Image size 1240x1240 · acquired on the Phoenix ICON · Phoenix ICON wide-field infant fundus image.
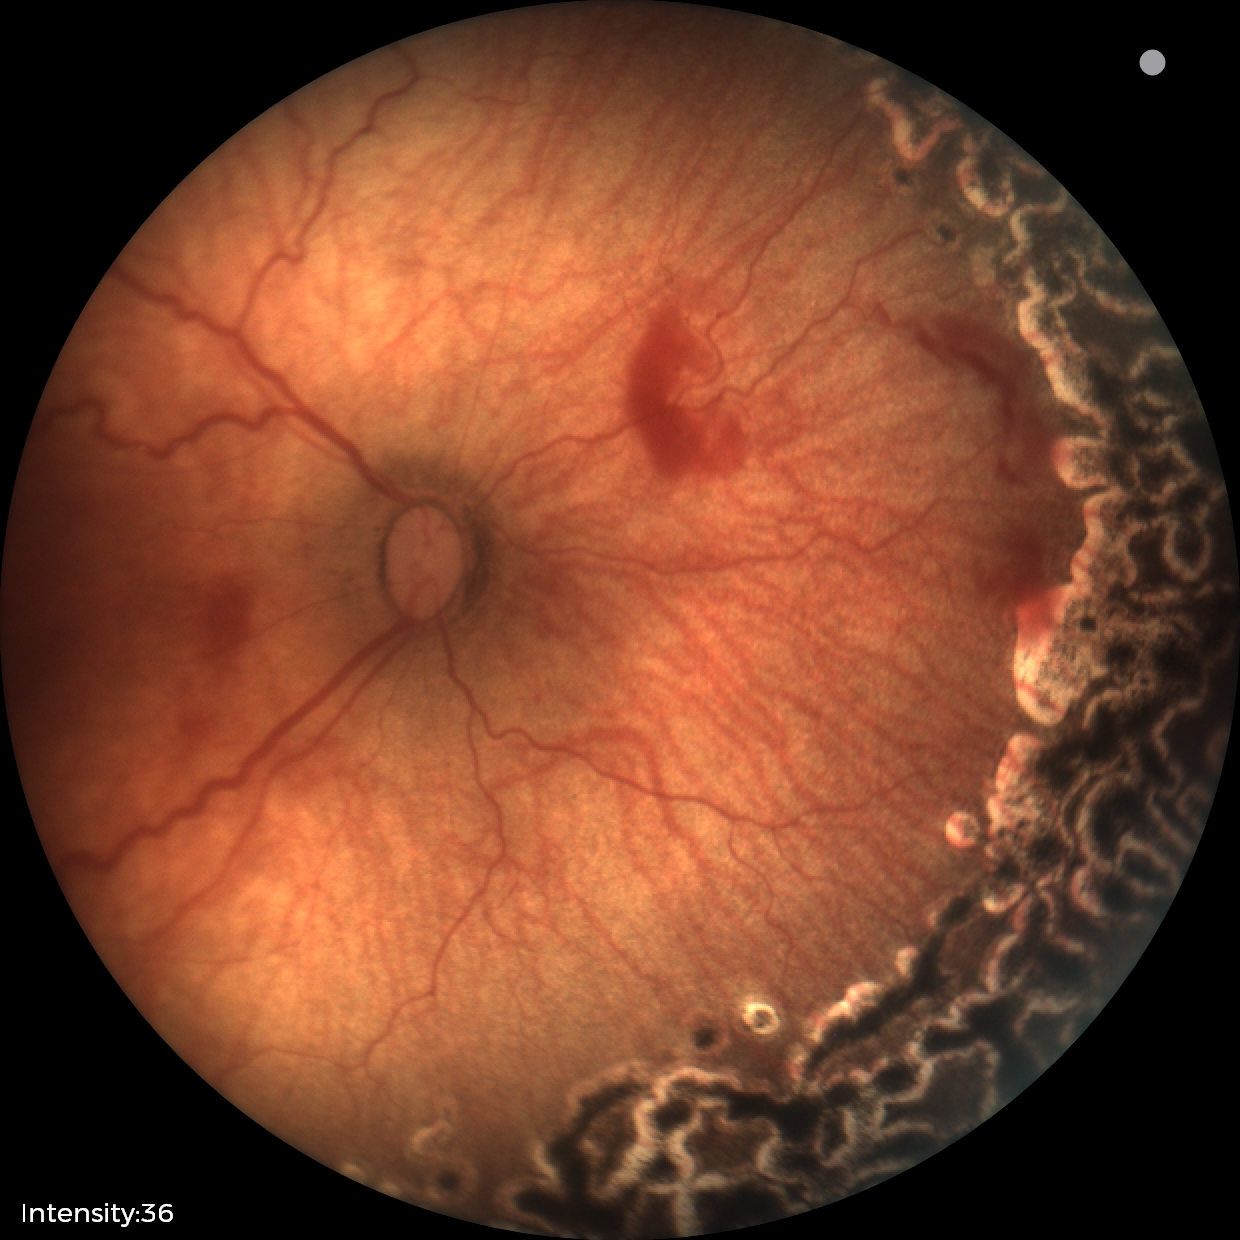
Q: What is the diagnosis from this examination?
A: status post retinopathy of prematurity — retinal appearance after treated retinopathy of prematurity
Q: Is plus disease present?
A: no plus disease — posterior pole vessels without abnormal dilation or tortuosity